CFP — 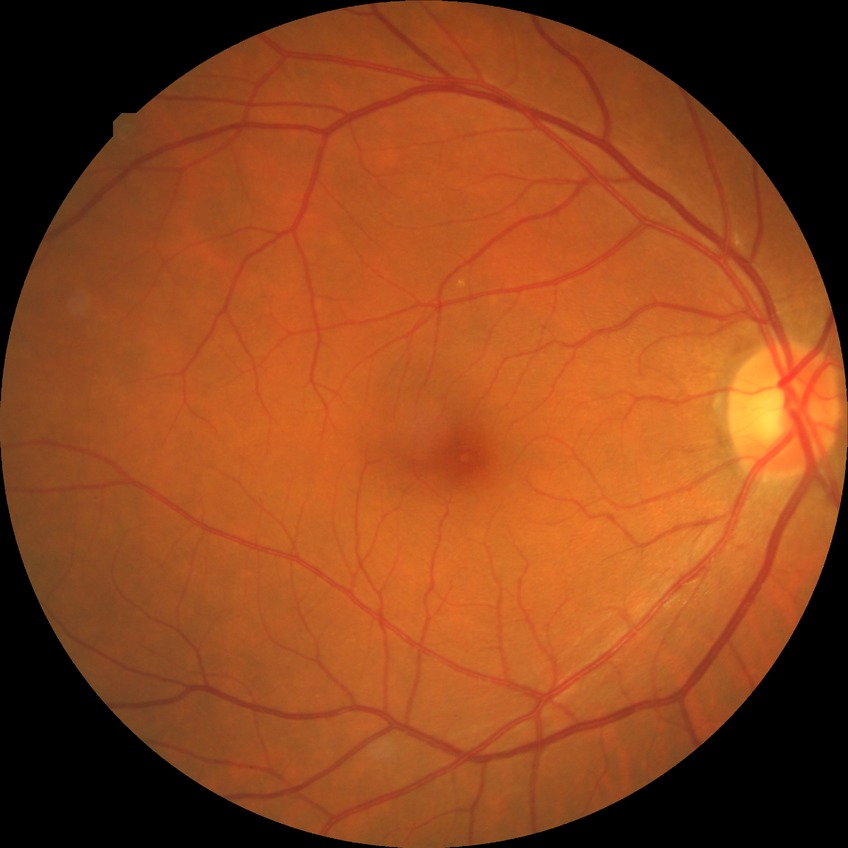
Diabetic retinopathy stage is no diabetic retinopathy.